Wide-field contact fundus photograph of an infant: 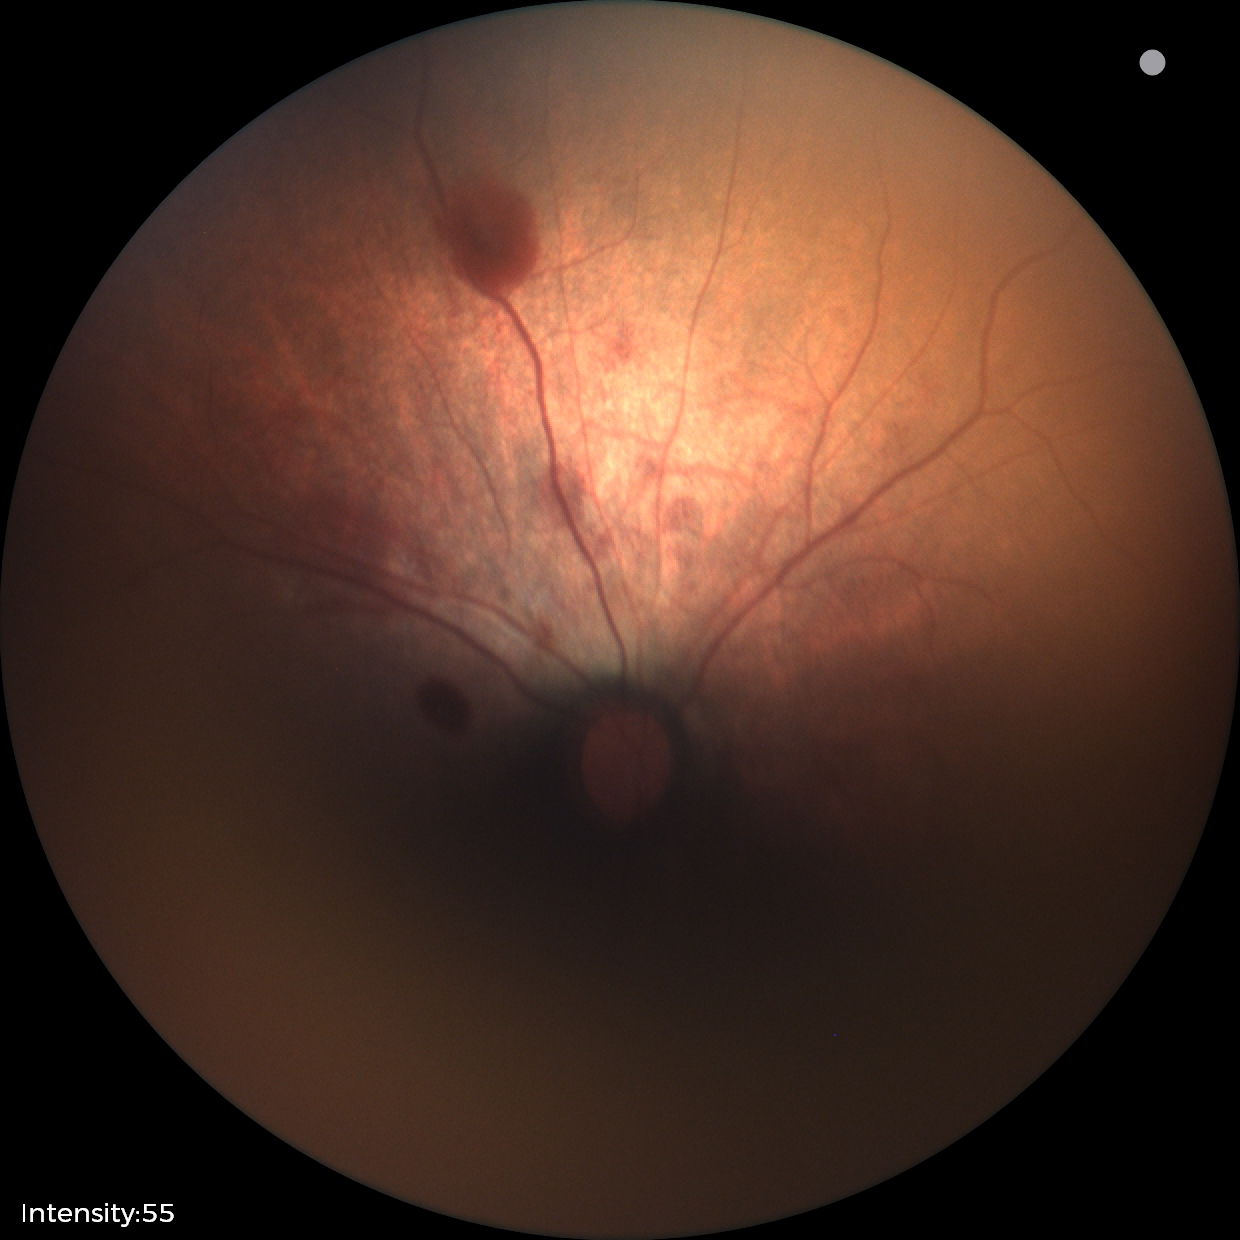

Examination diagnosed as retinal hemorrhages.